Color fundus image; 2352x1568; 45° FOV: 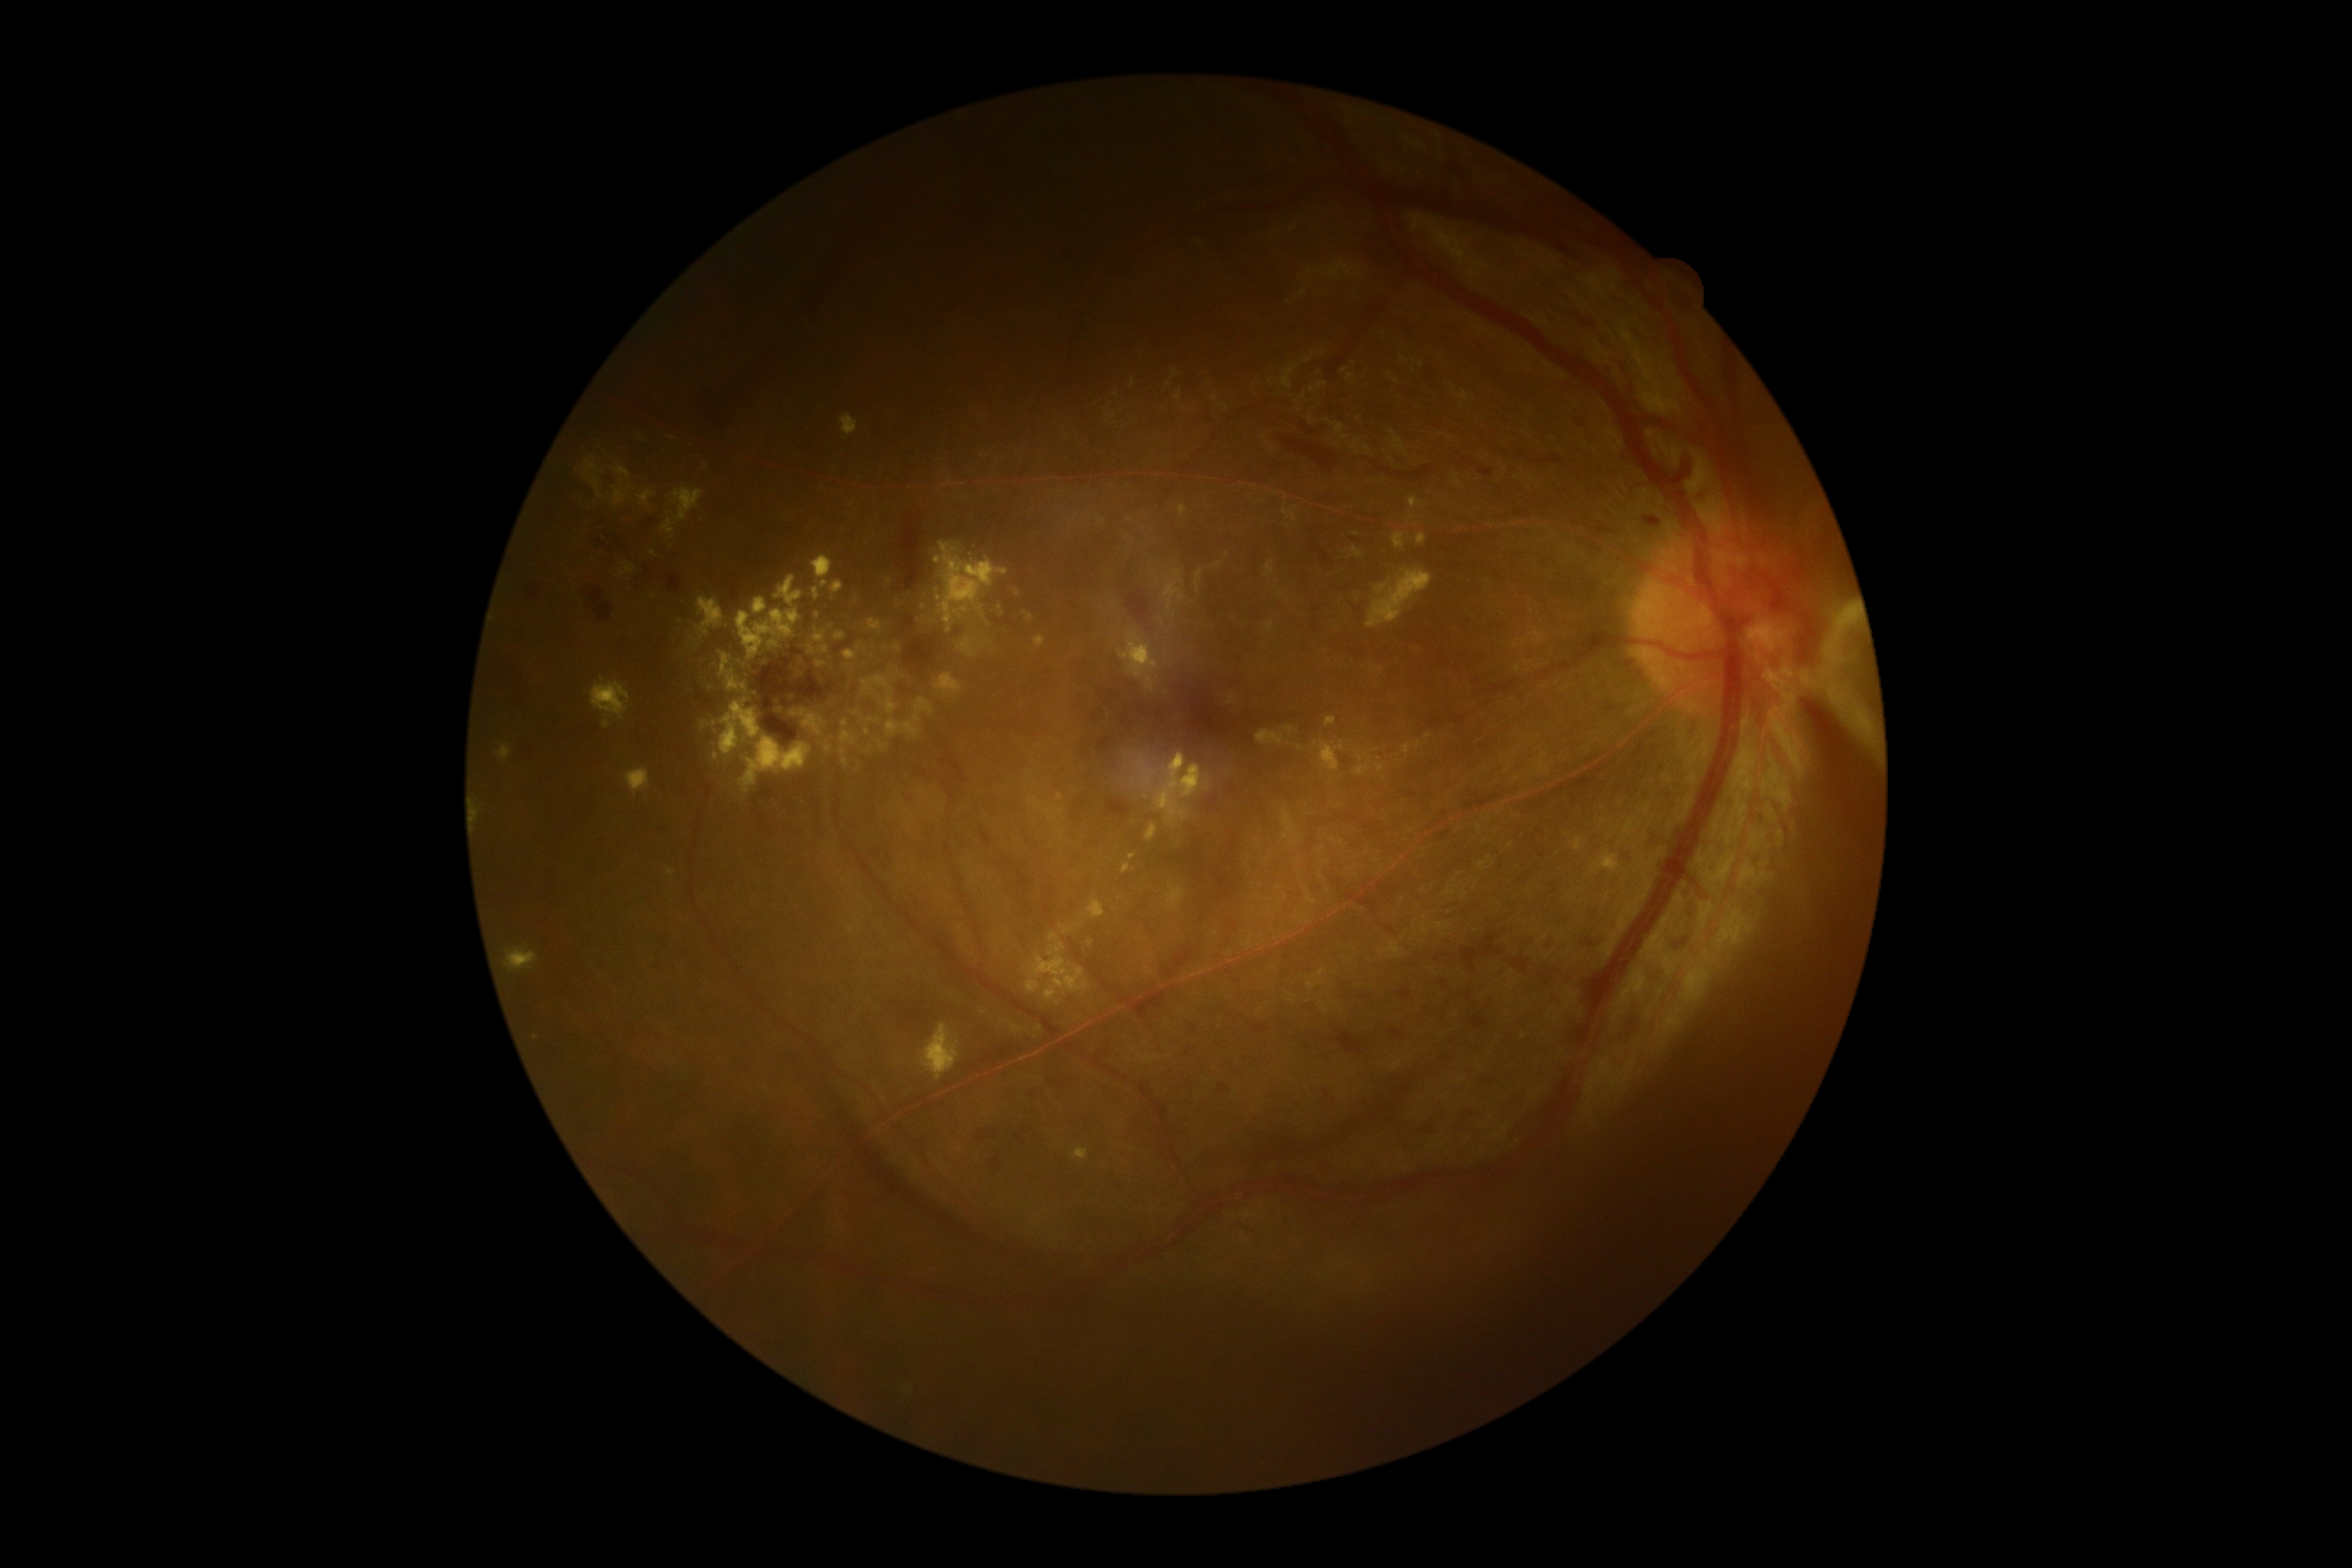 {
  "dr_grade": "proliferative diabetic retinopathy (grade 4)"
}